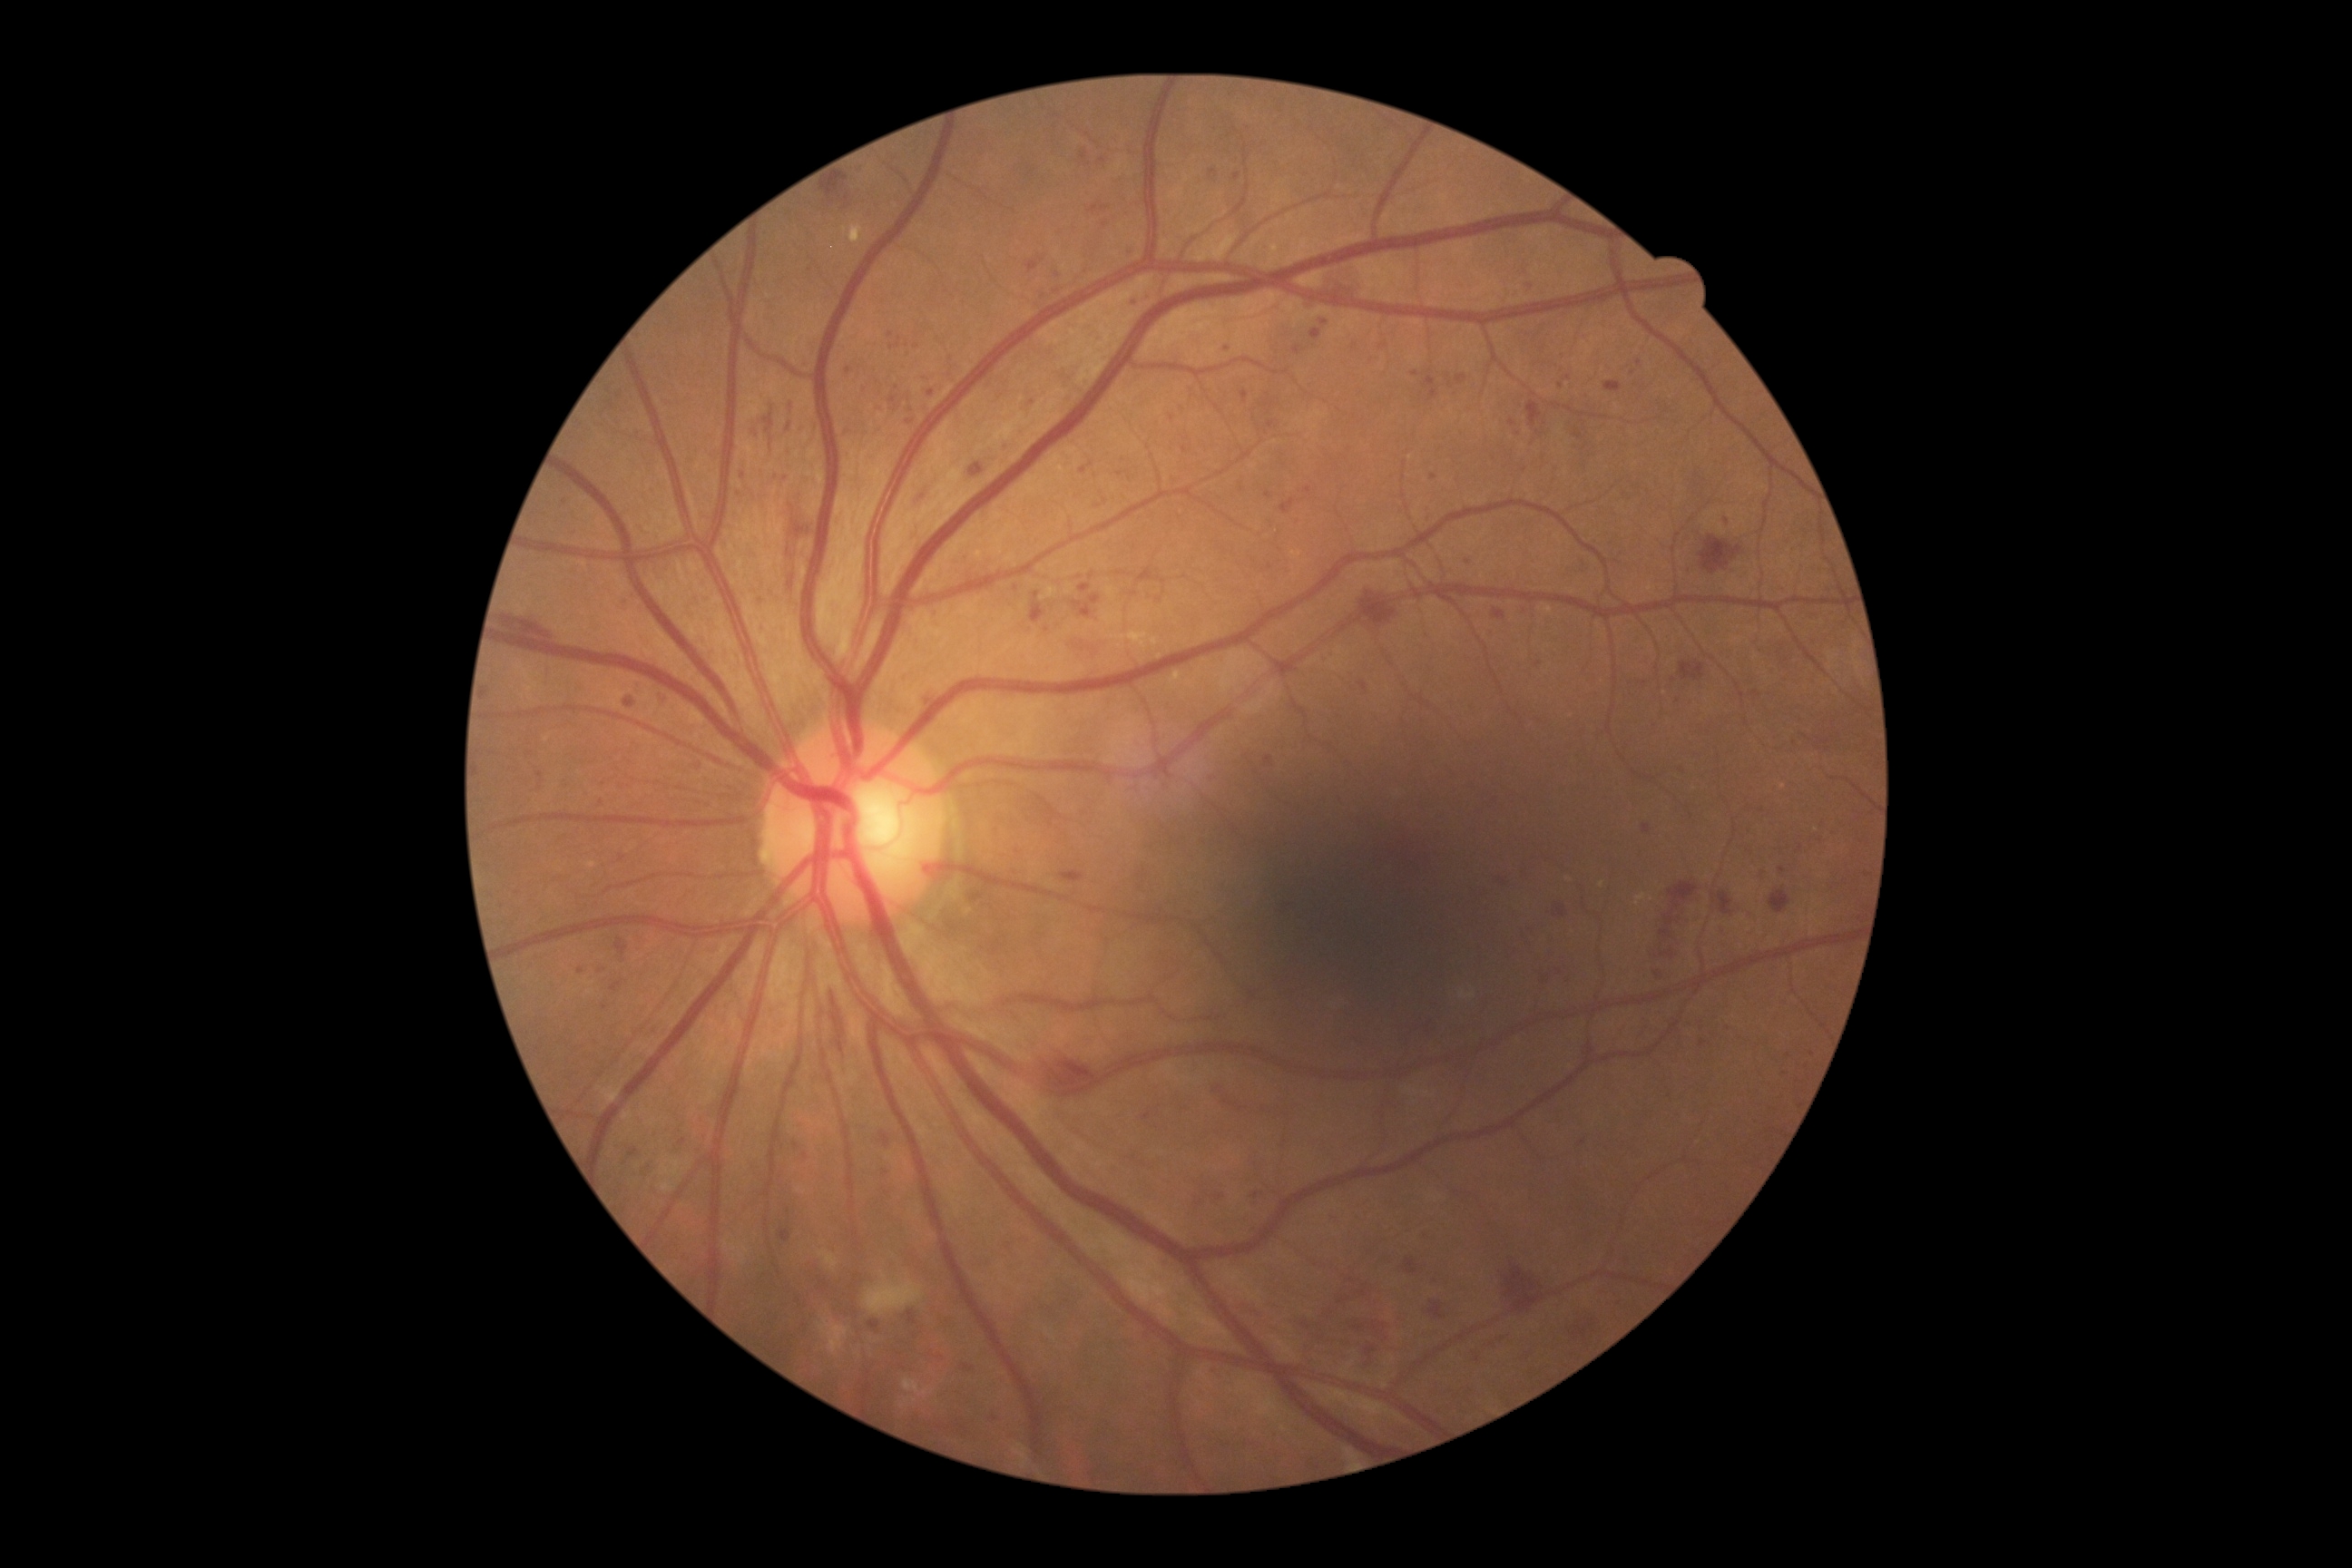

DR grade: 3 (severe NPDR)
A subset of detected lesions:
* MAs (more not shown): rect(1424, 377, 1440, 400), rect(1542, 981, 1551, 986), rect(1079, 585, 1092, 593), rect(779, 1230, 792, 1242), rect(787, 402, 798, 413), rect(1242, 391, 1248, 404), rect(1643, 825, 1651, 834), rect(611, 983, 623, 992)
* Additional small MAs near [622,858], [886,1173], [1364,1294], [1269,761], [1185,450], [806,1156], [1634,373], [1102,161], [1502,882], [1812,1054], [1490,635]
* HEs (more not shown): rect(823, 175, 848, 197), rect(1718, 892, 1734, 916), rect(1429, 1302, 1444, 1320), rect(972, 466, 983, 476), rect(1355, 591, 1396, 625), rect(1493, 609, 1505, 620), rect(1244, 1306, 1260, 1320), rect(1406, 1260, 1418, 1275), rect(1574, 1309, 1596, 1344), rect(1037, 1043, 1097, 1092), rect(828, 990, 848, 1075), rect(504, 616, 553, 640)